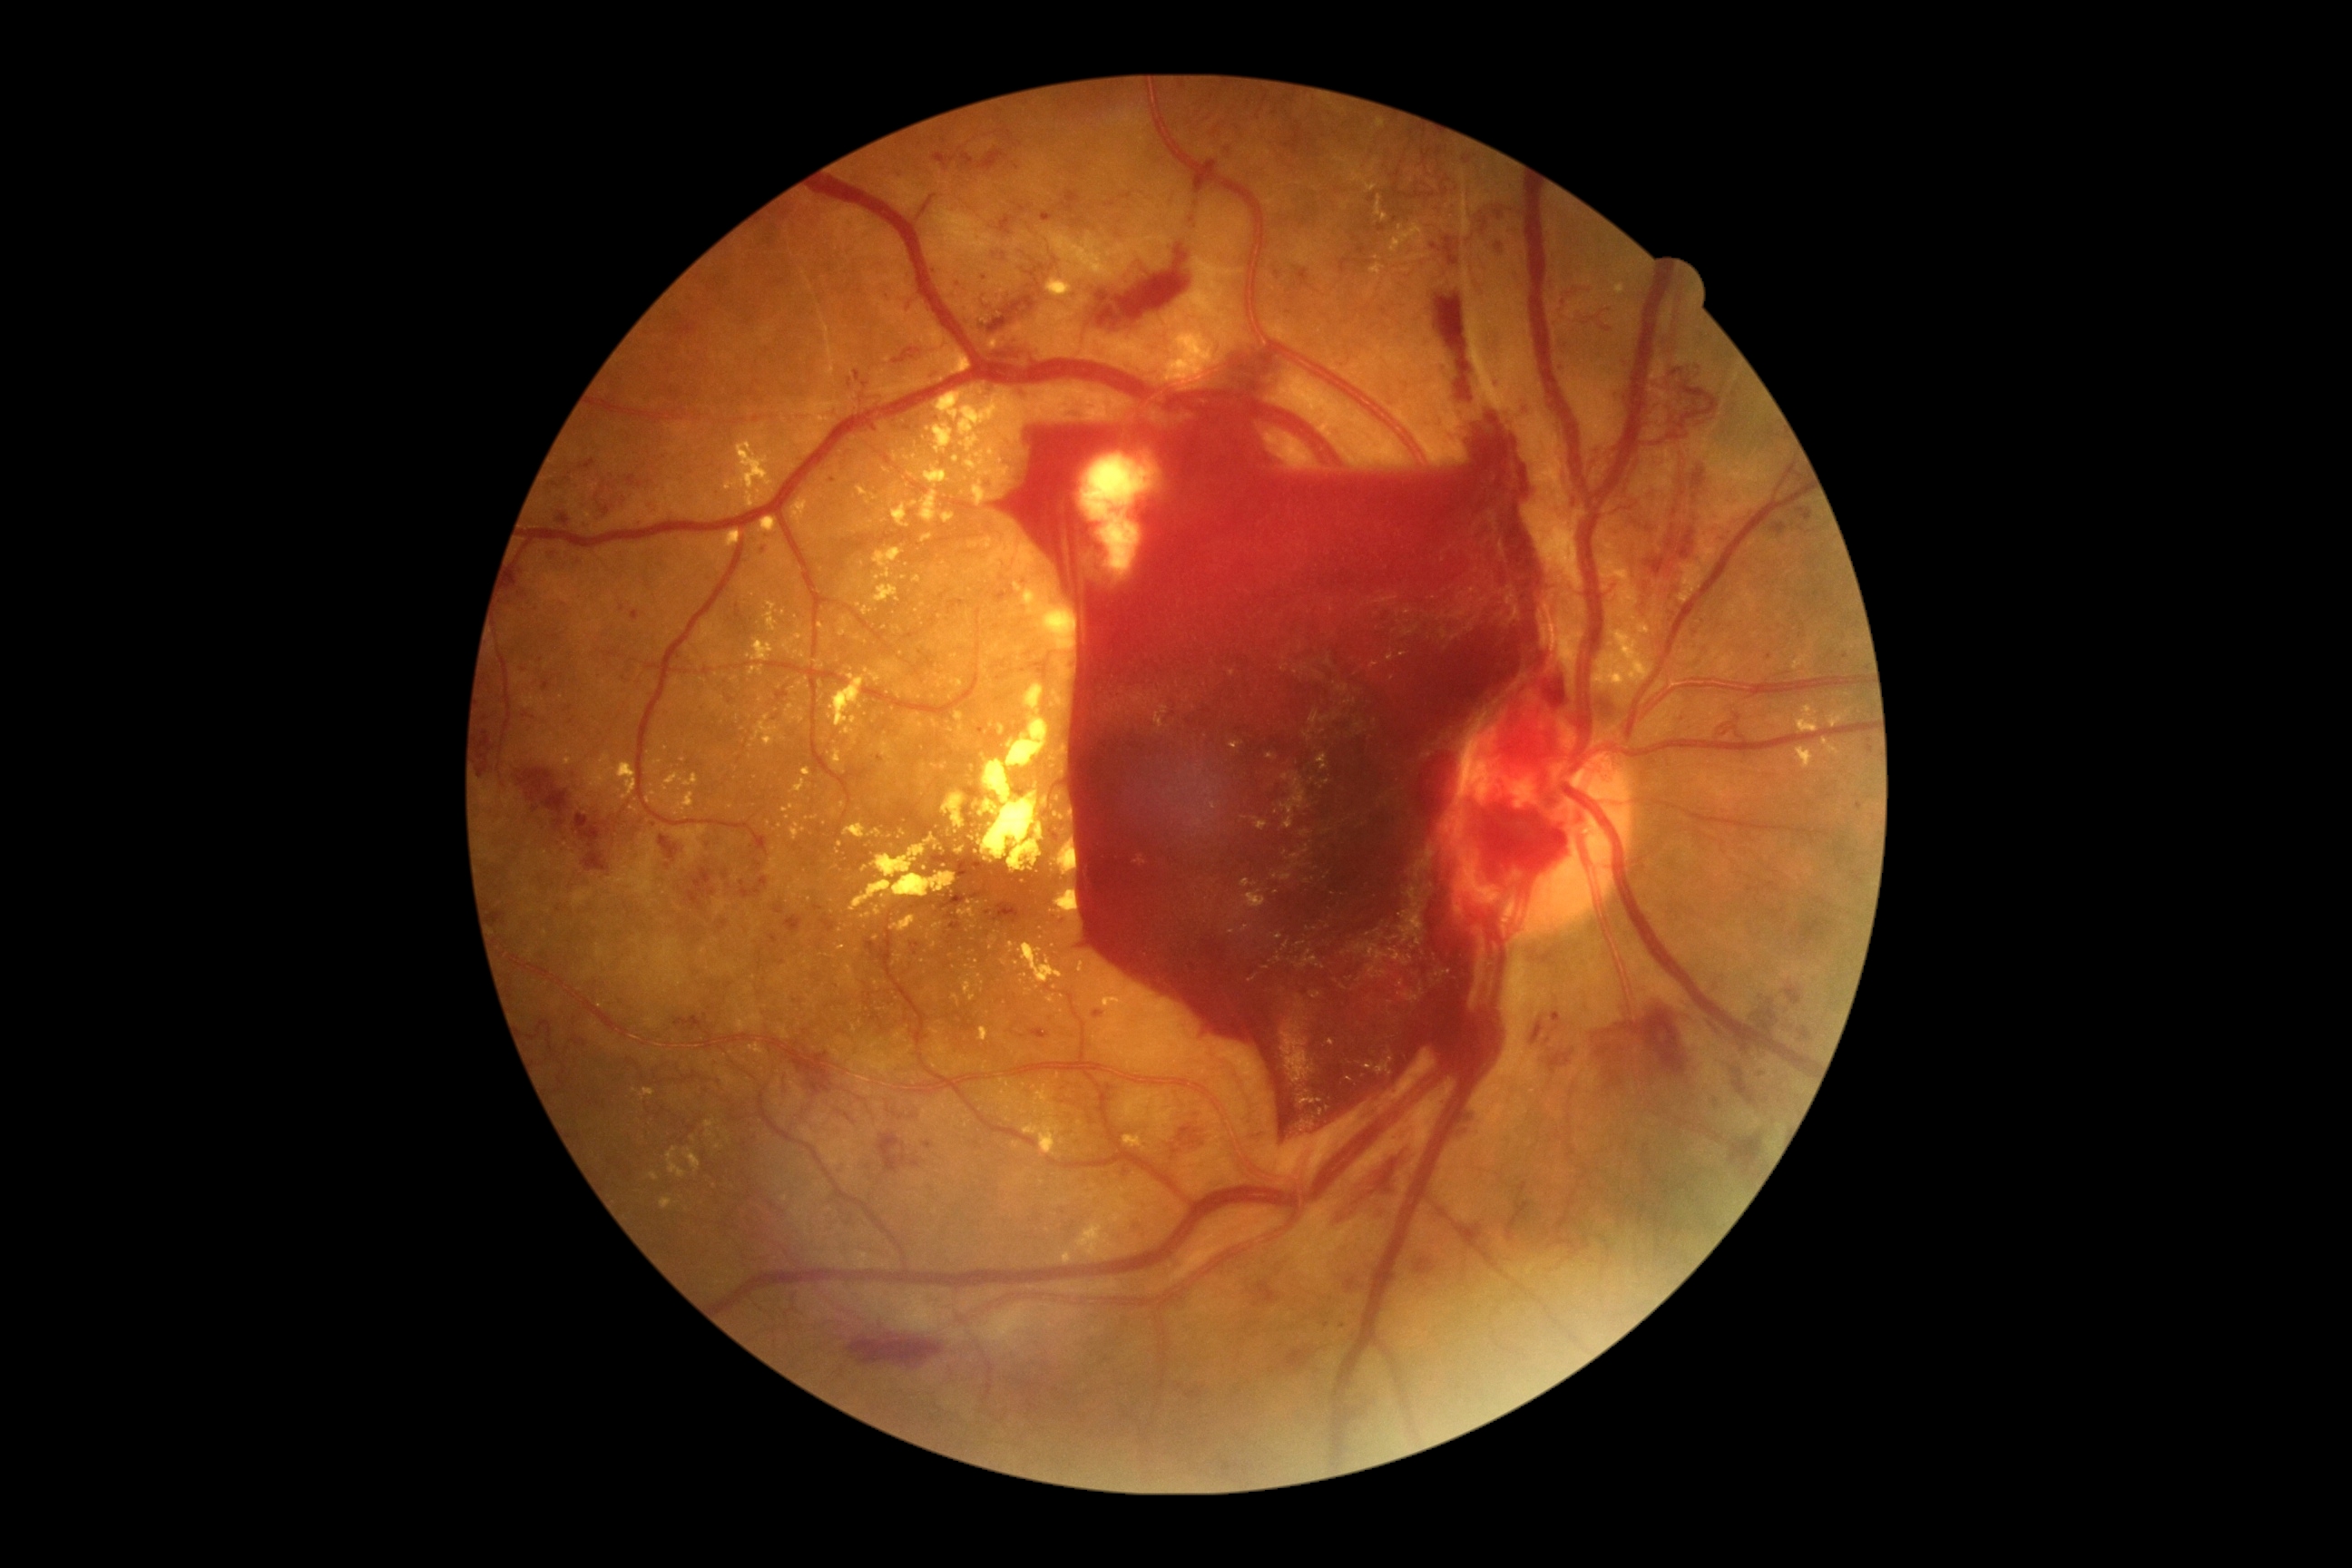 Disease class: proliferative diabetic retinopathy.
Diabetic retinopathy grade: 4/4 — neovascularization and/or vitreous/pre-retinal hemorrhage.